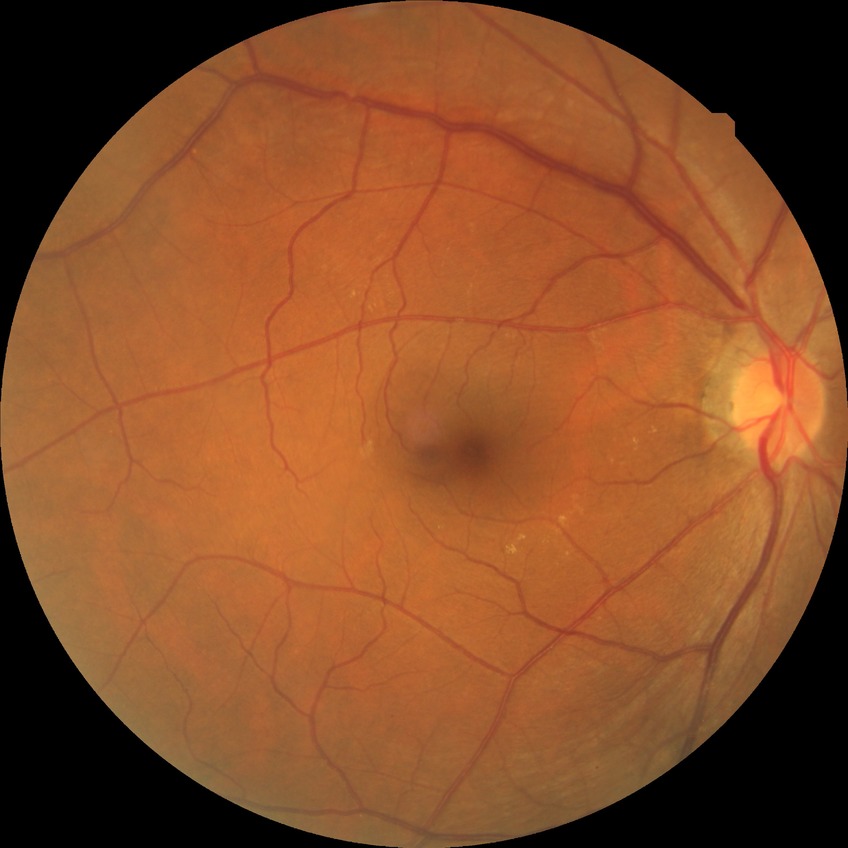

No diabetic retinal disease findings.
DR: NDR.